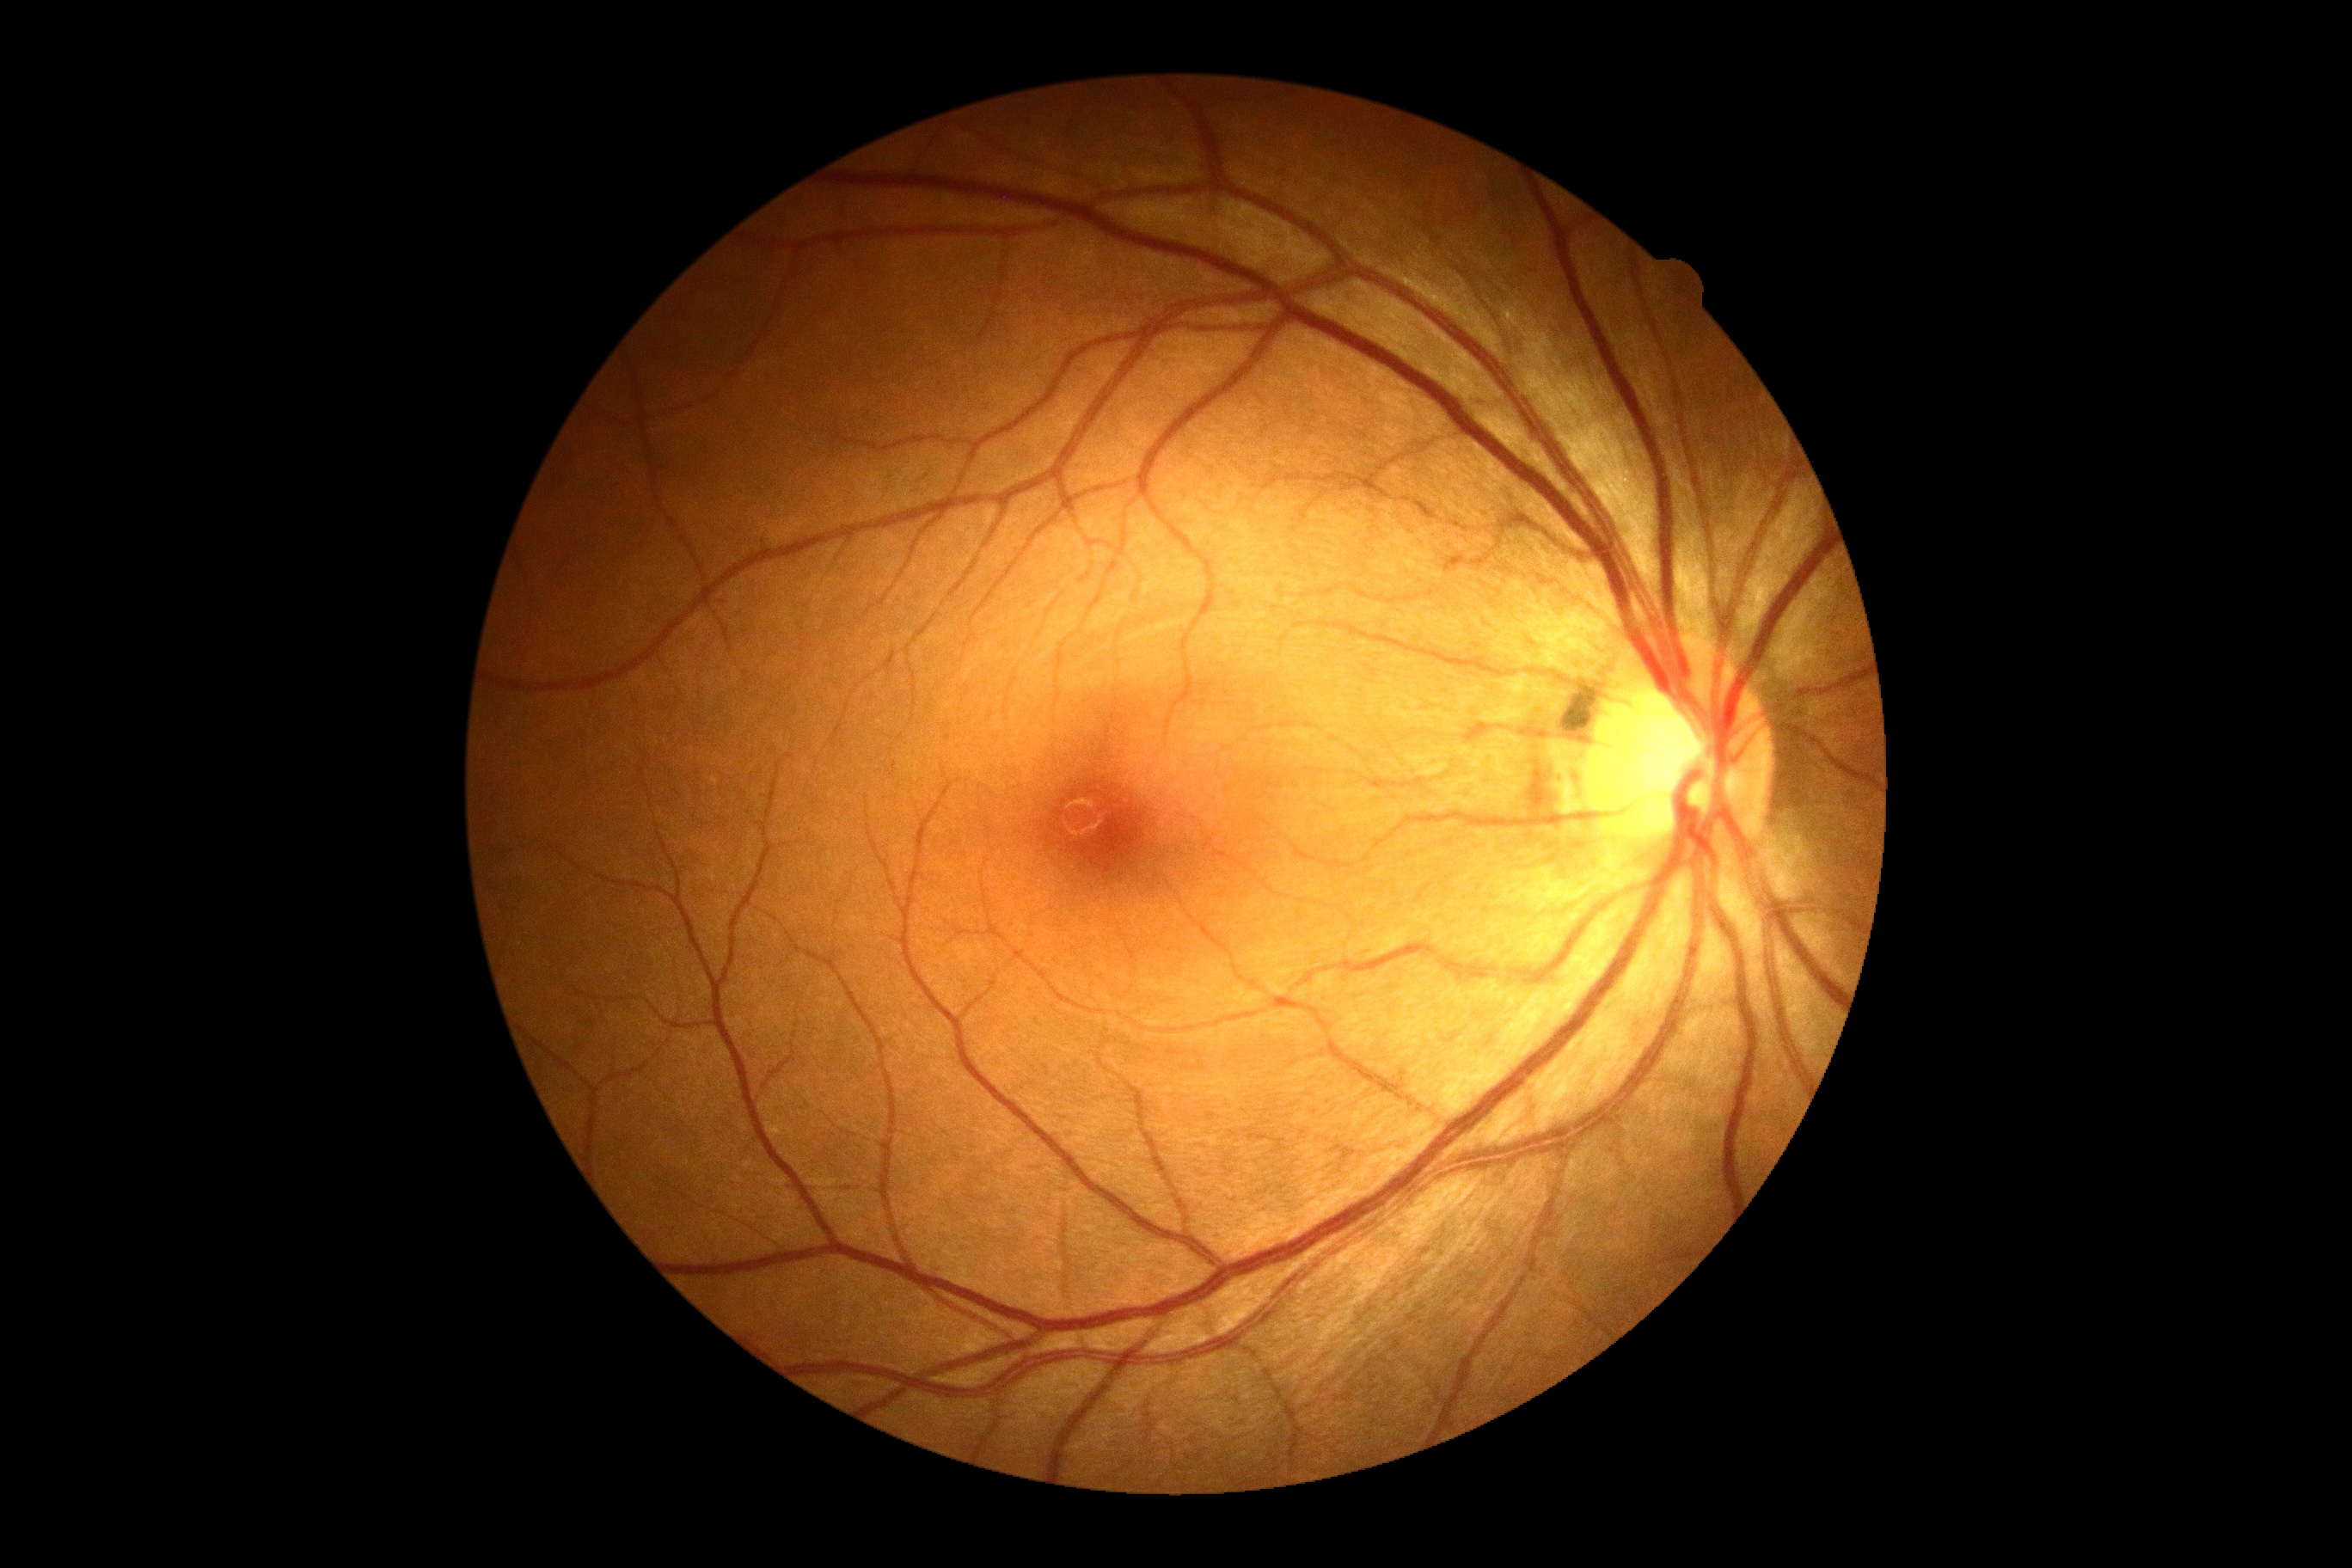
* diabetic retinopathy grade: 0 — no visible signs of diabetic retinopathy